Acquired on the Phoenix ICON; pediatric wide-field fundus photograph; 1240x1240px:
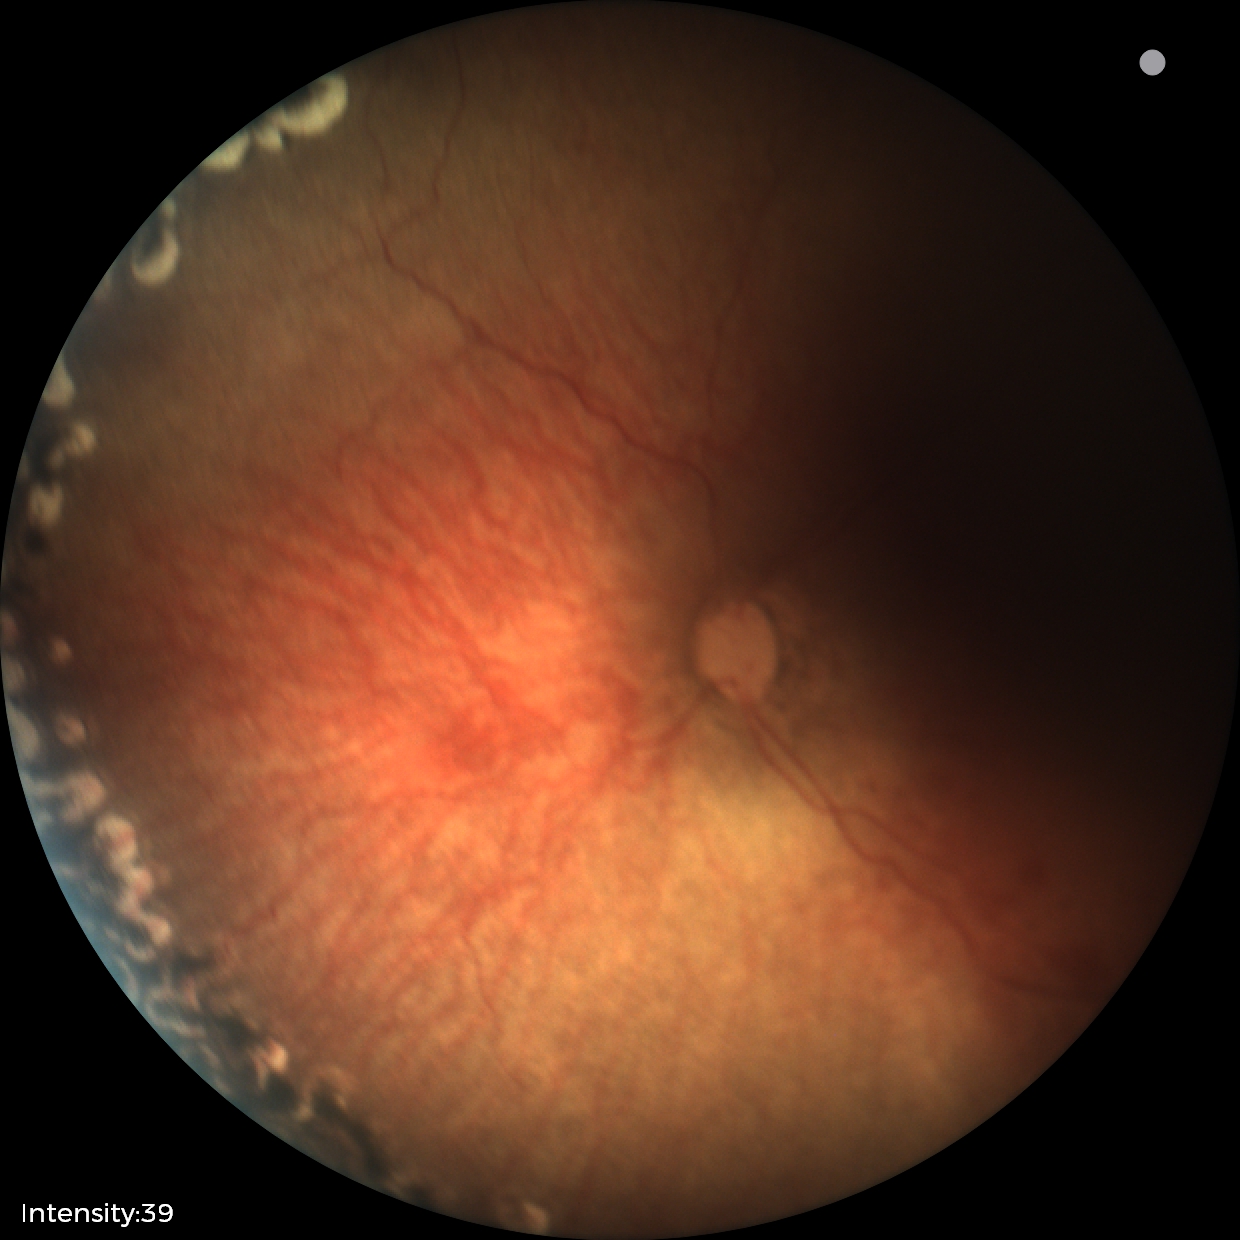

Examination diagnosed as status post retinopathy of prematurity (ROP). No plus disease.